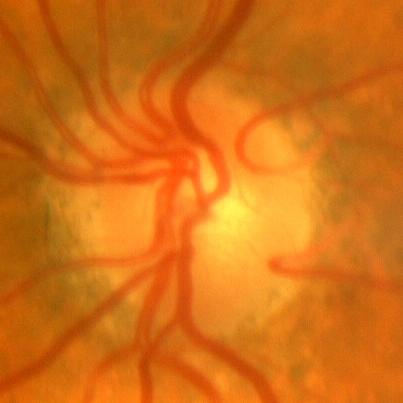

Q: What is the glaucoma diagnosis?
A: No — no glaucomatous changes.